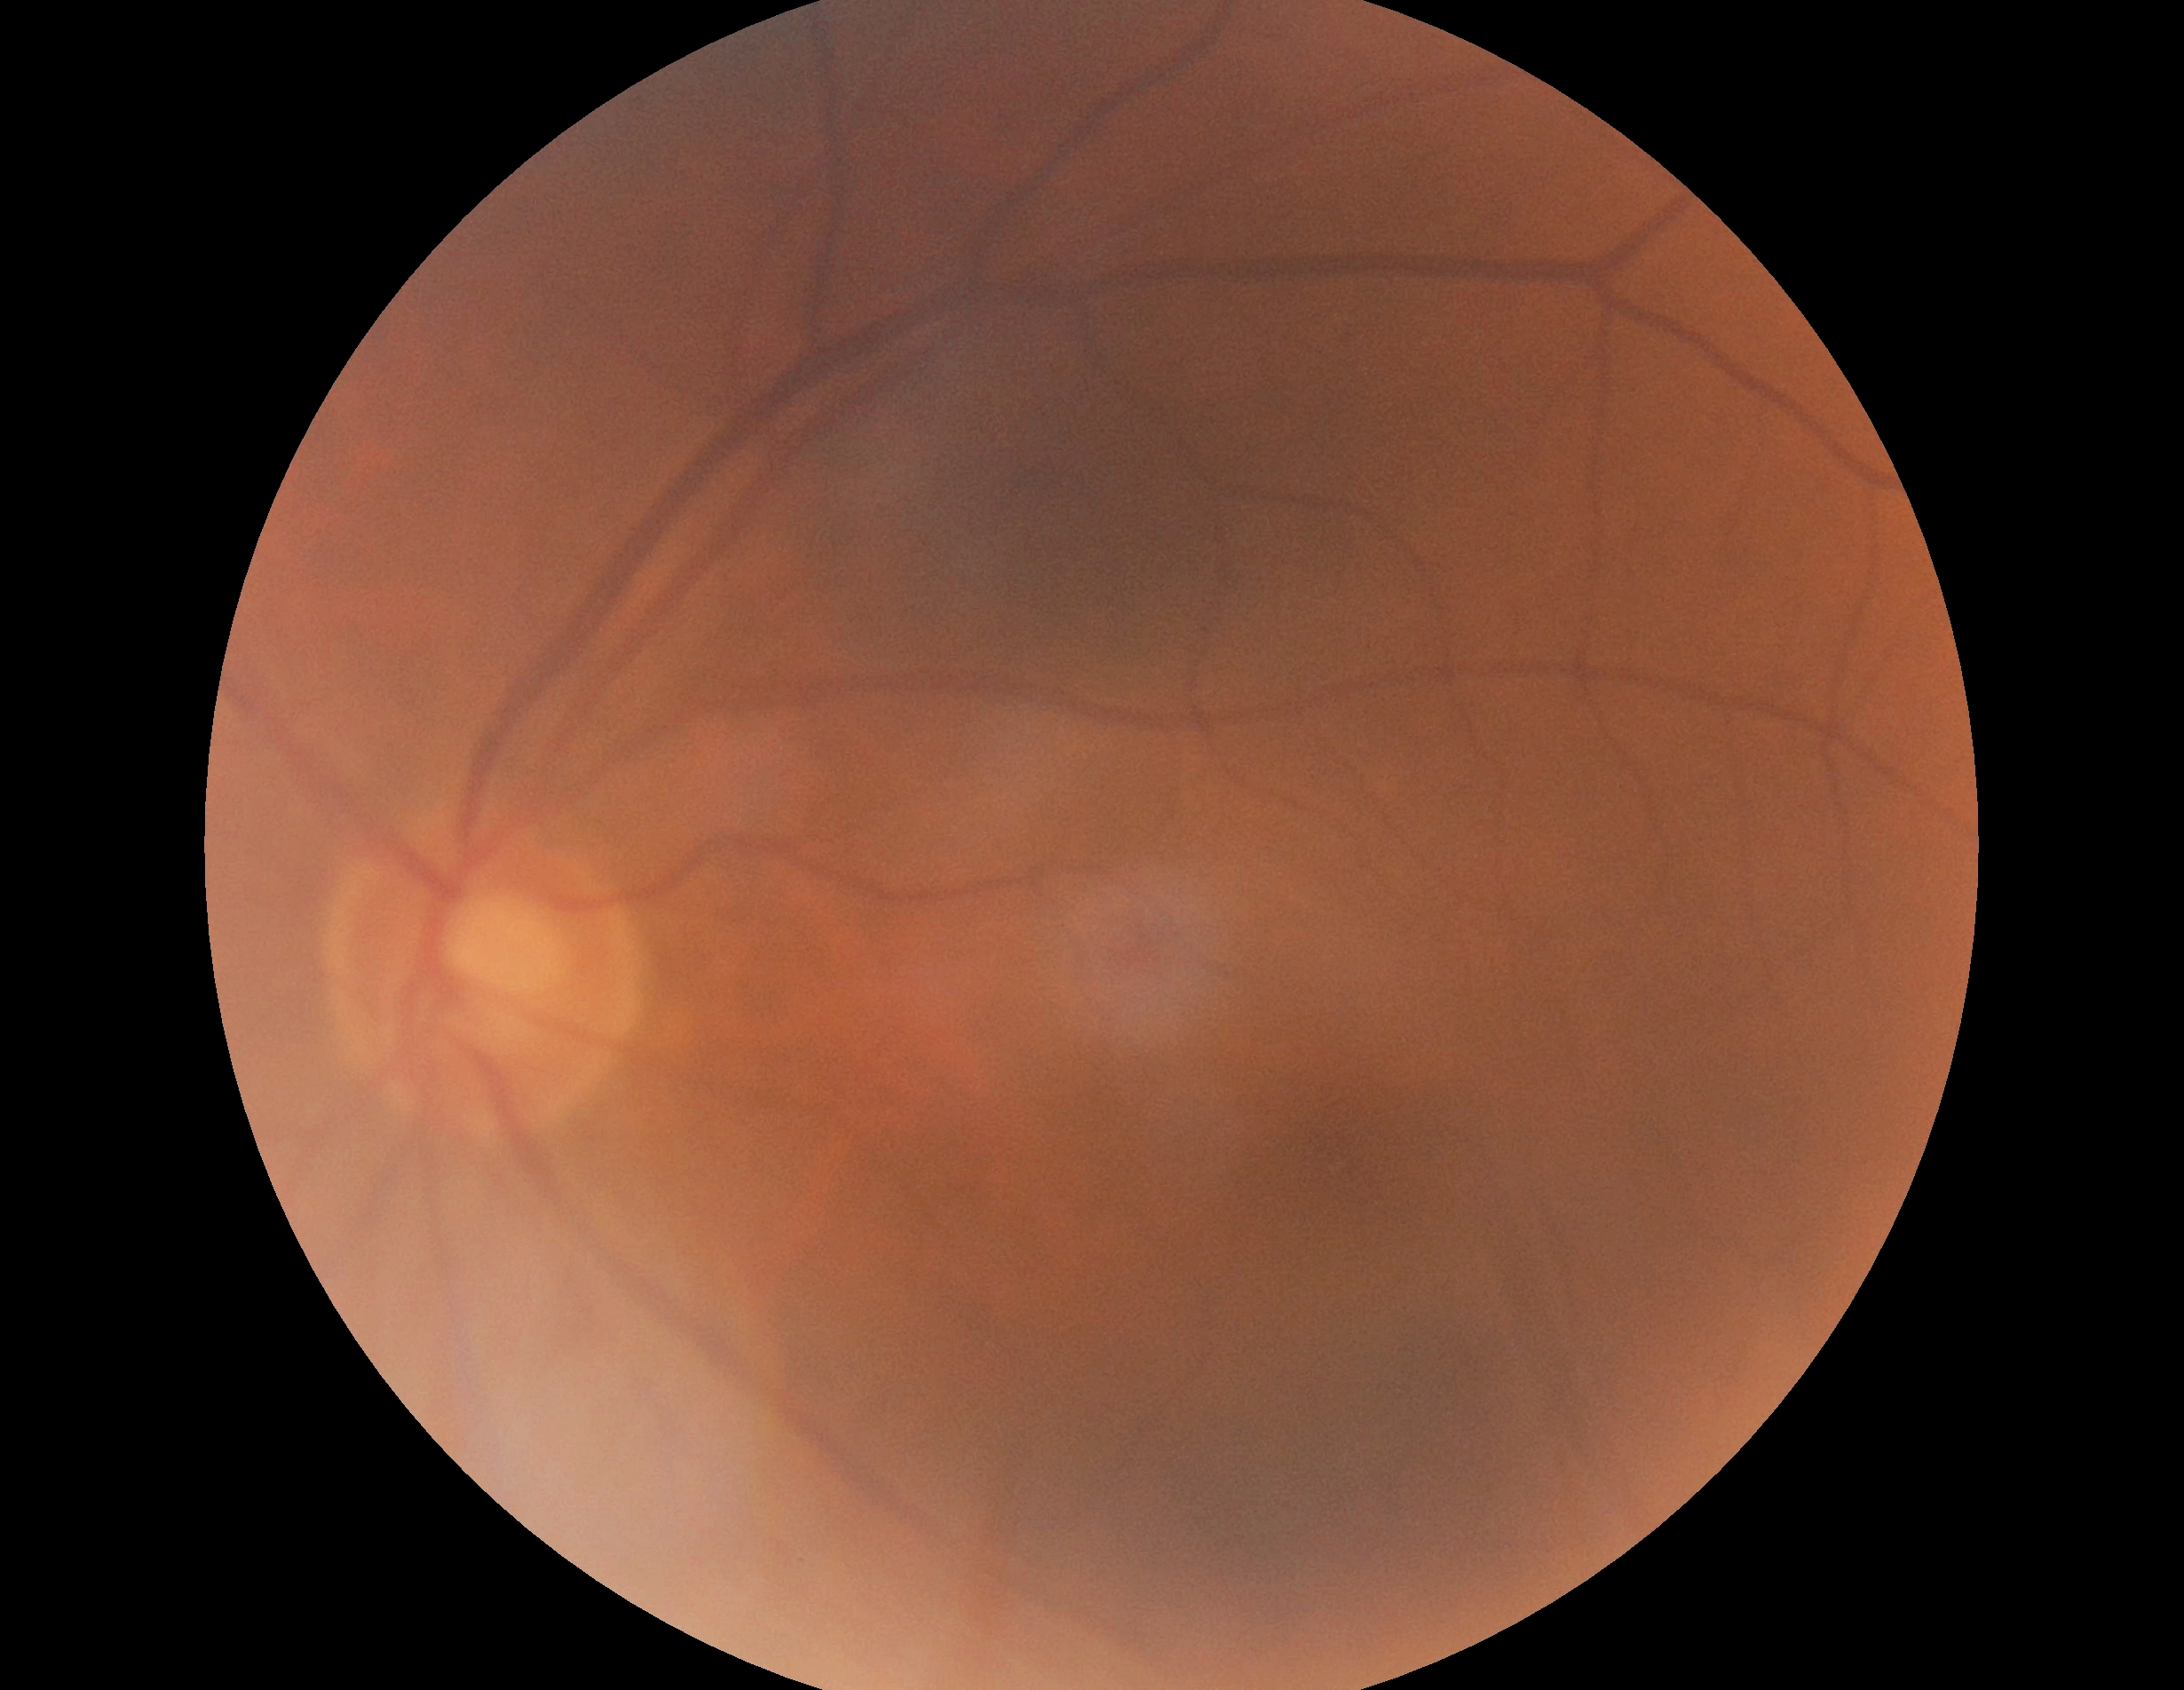
DR: no apparent diabetic retinopathy (grade 0). No DR findings.